FOV: 45 degrees; no pharmacologic dilation; 848 by 848 pixels; NIDEK AFC-230; posterior pole photograph.
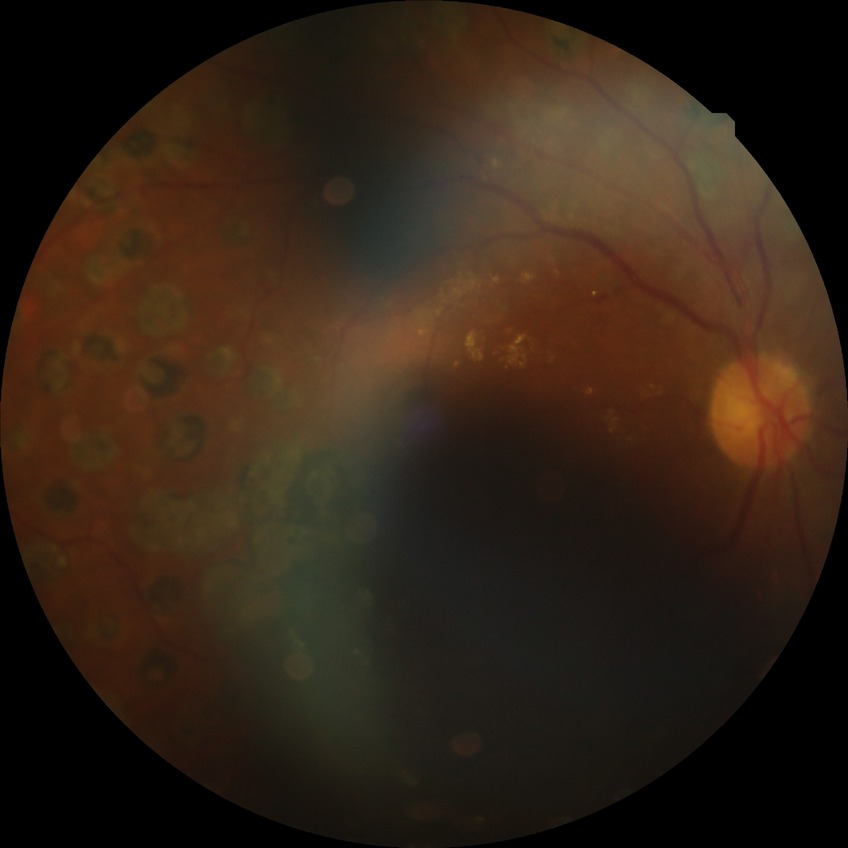 diabetic retinopathy (DR): proliferative diabetic retinopathy (PDR)